45-degree field of view; graded on the modified Davis scale; color fundus photograph.
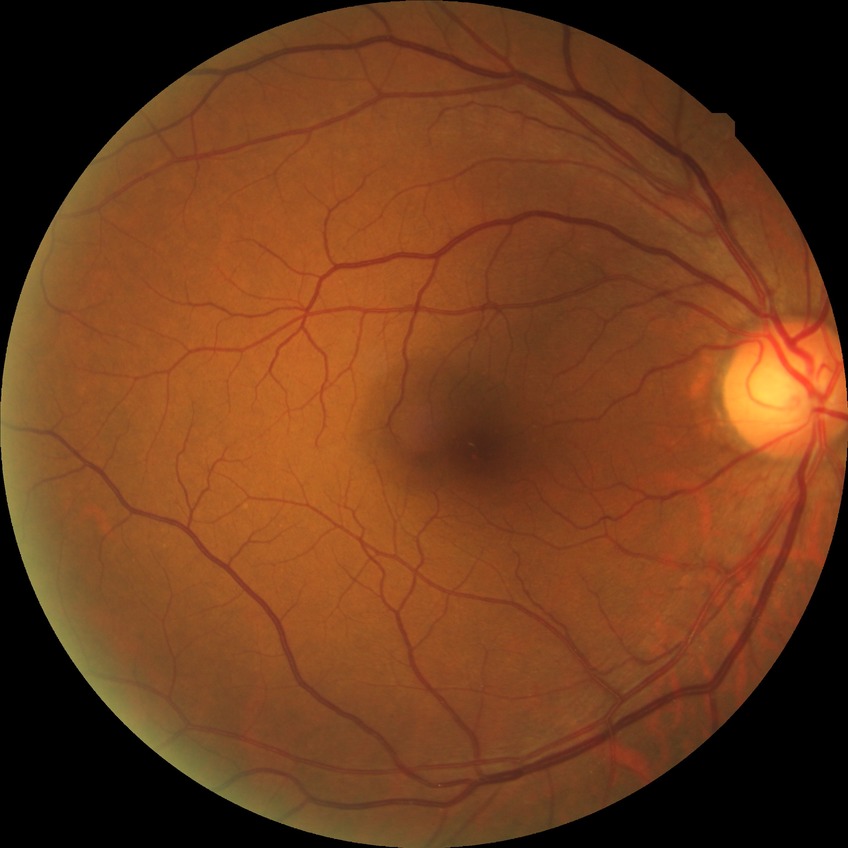 diabetic retinopathy (DR) = NDR (no diabetic retinopathy)